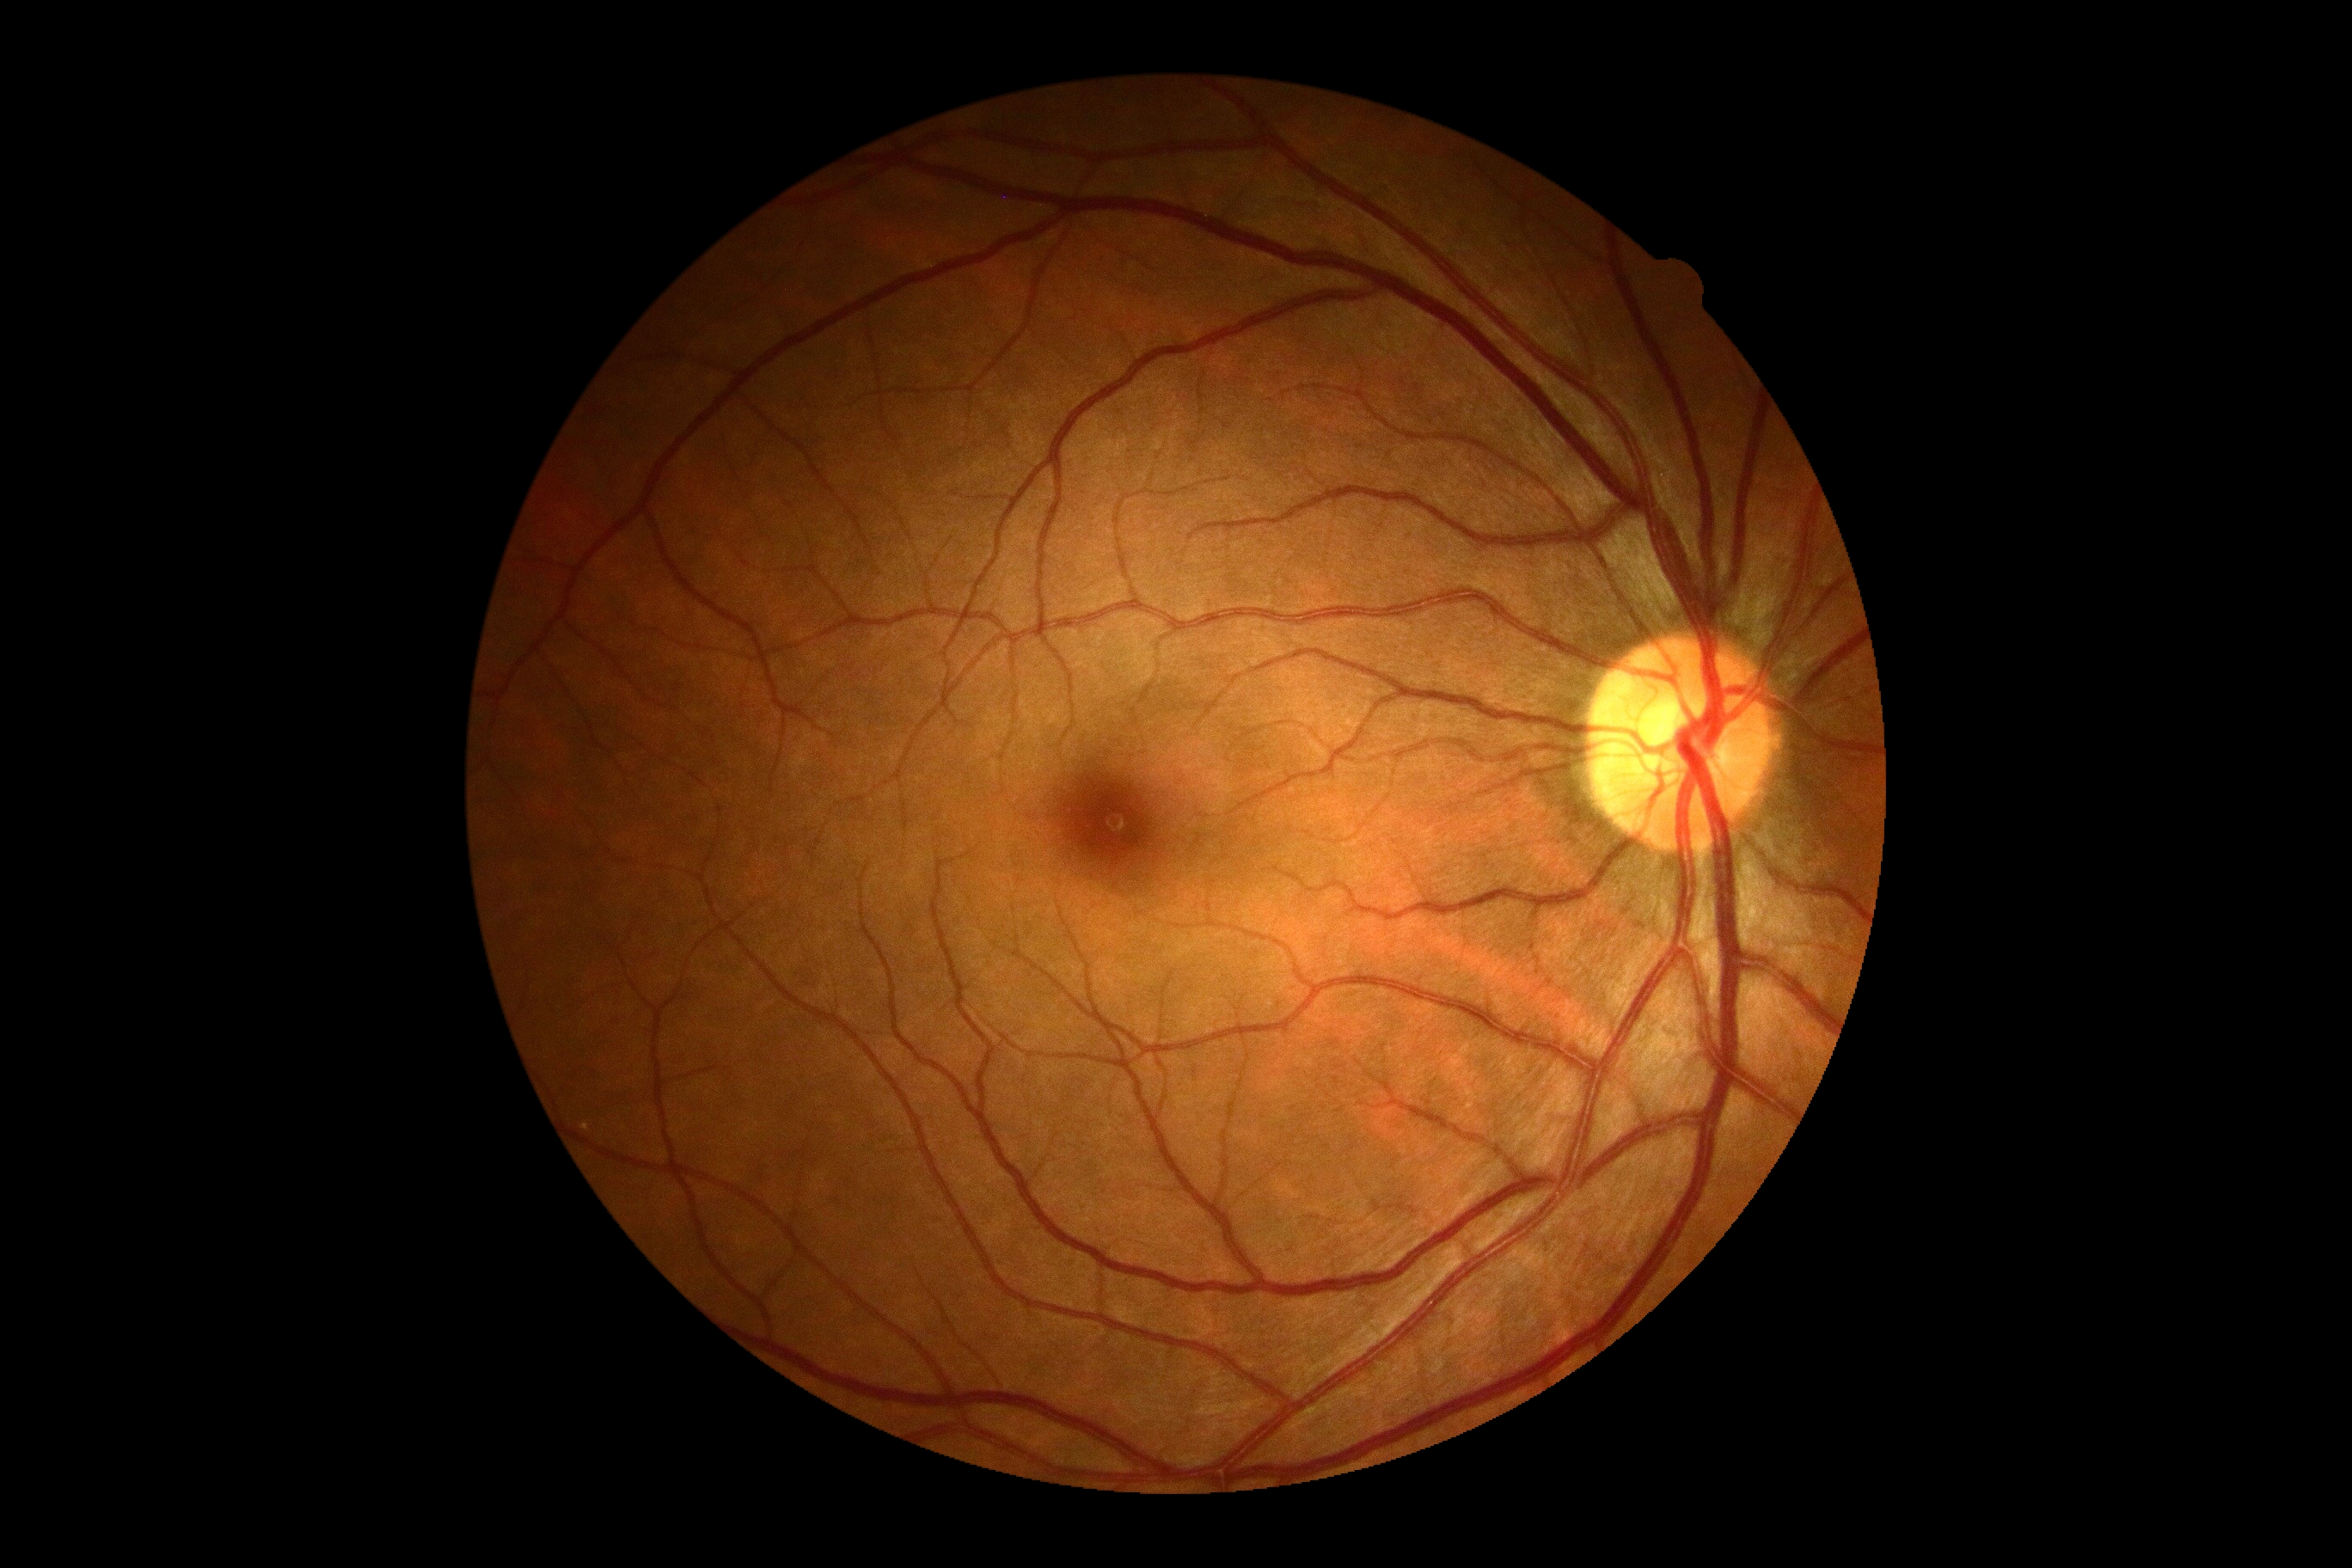
DR grade: no apparent diabetic retinopathy (0).